640x480; RetCam wide-field infant fundus image:
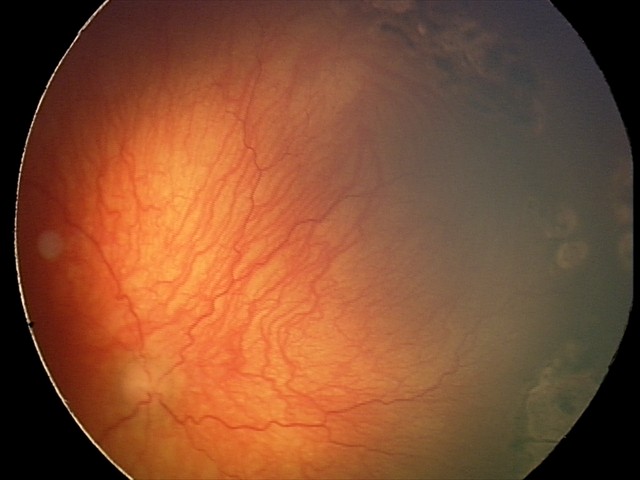

Impression: plus disease; aggressive ROP (A-ROP).